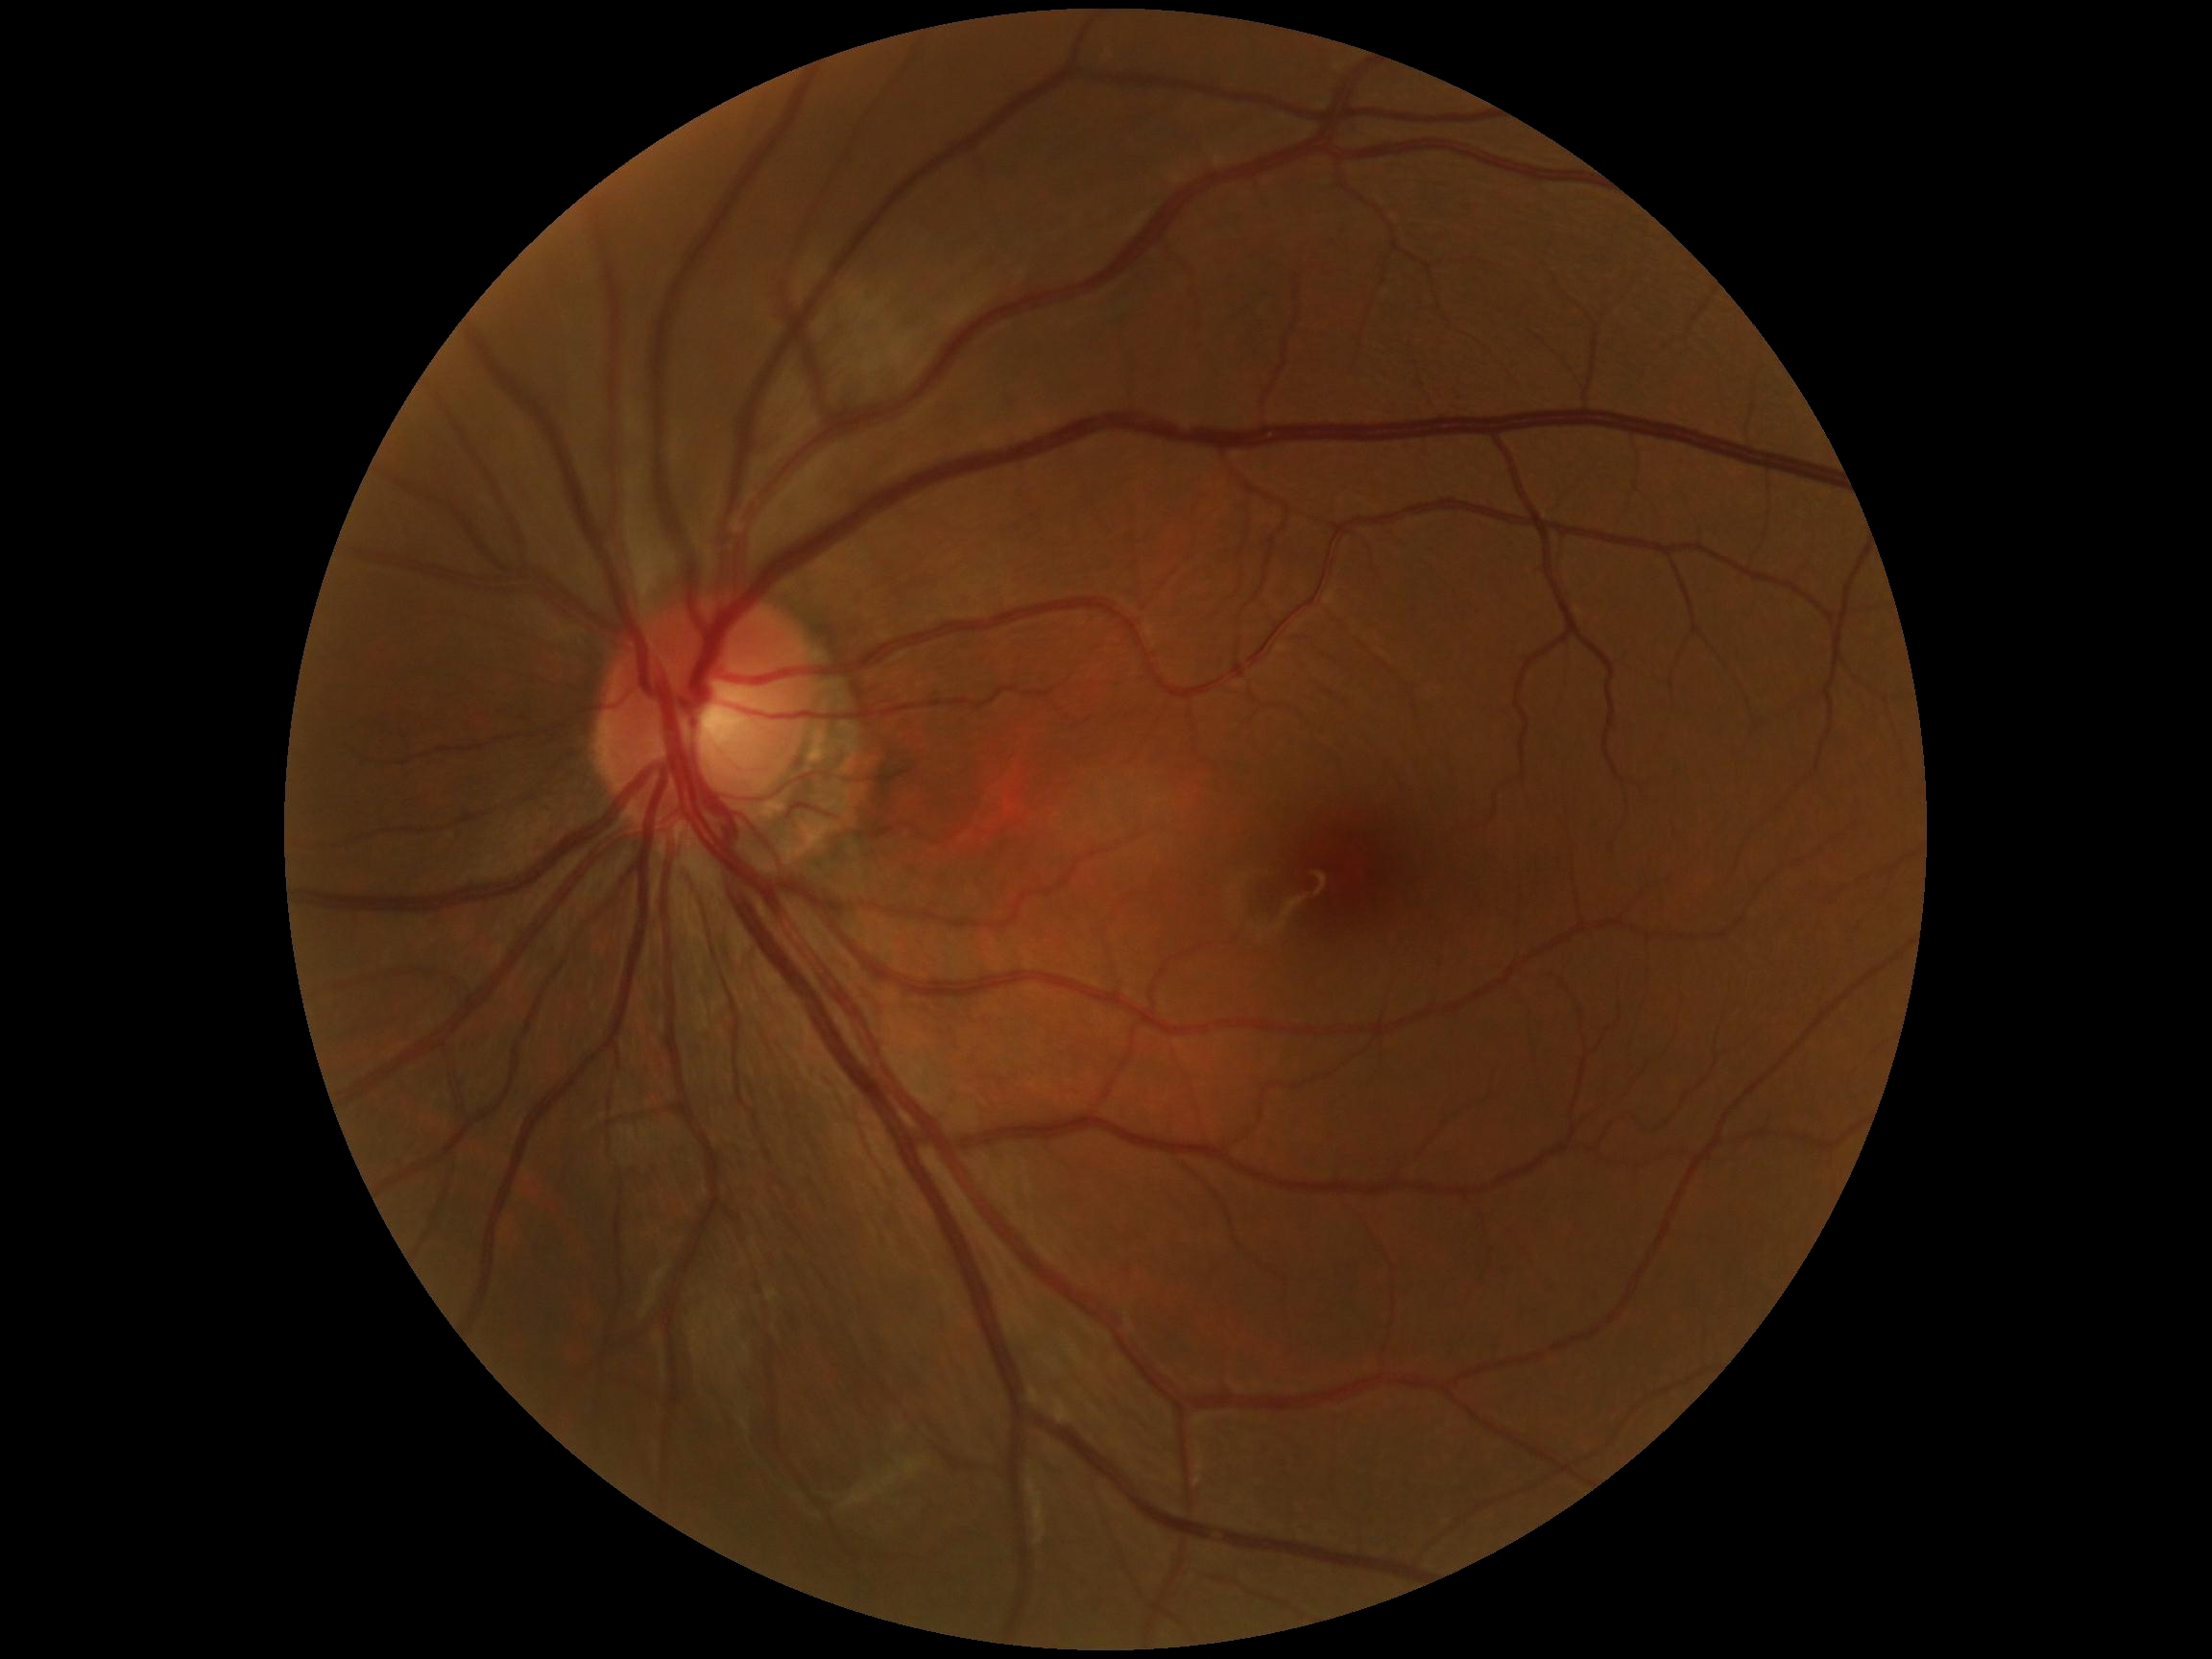

Diabetic retinopathy (DR) is 0.